Retinal fundus photograph.
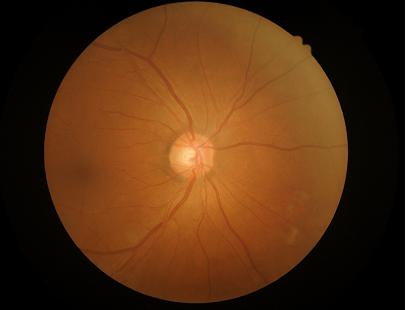

overall_quality: adequate
contrast: good
clarity: sharp